Nonmydriatic fundus photograph; retinal fundus photograph
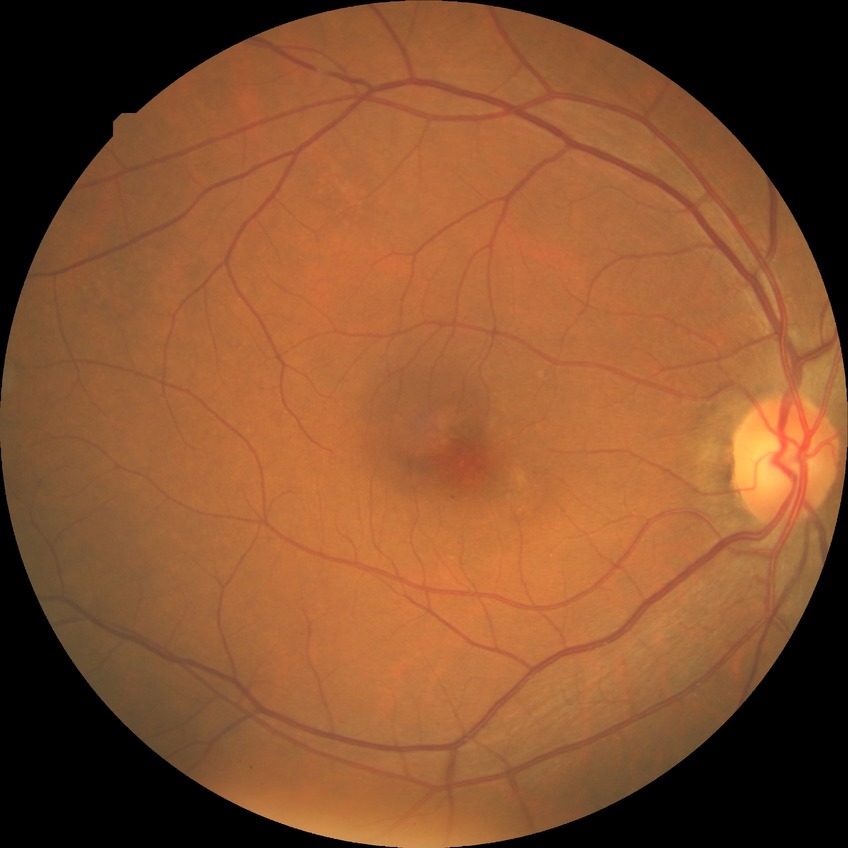

Diabetic retinopathy (DR): no diabetic retinopathy (NDR).